Retinal fundus photograph; 848x848px
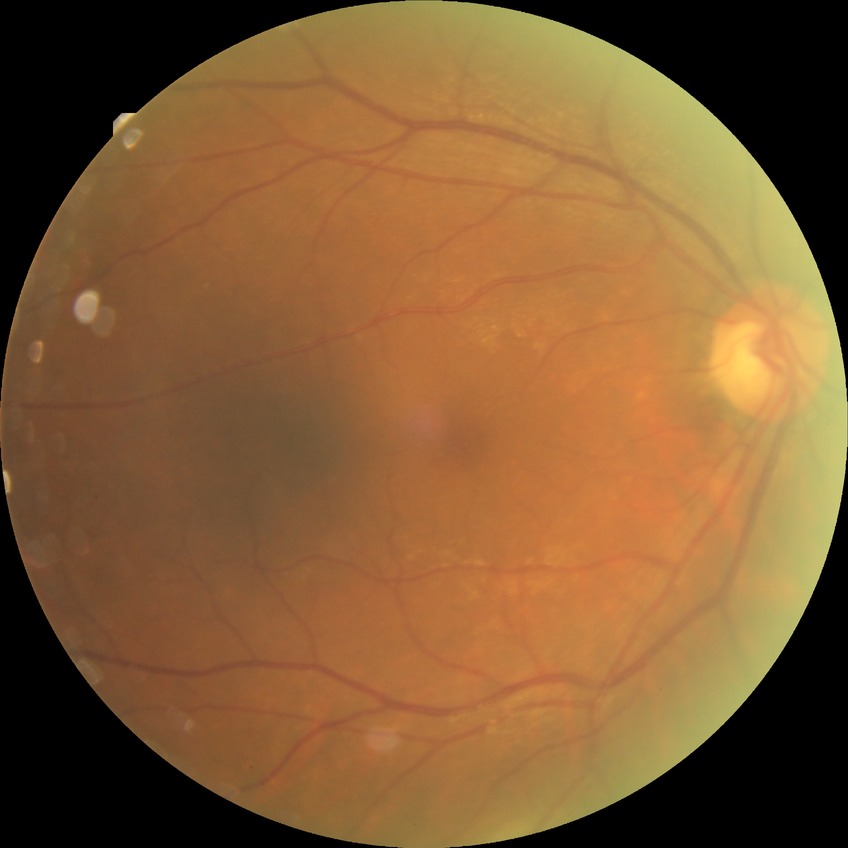 Diabetic retinopathy (DR): no diabetic retinopathy (NDR).